Retinal fundus photograph
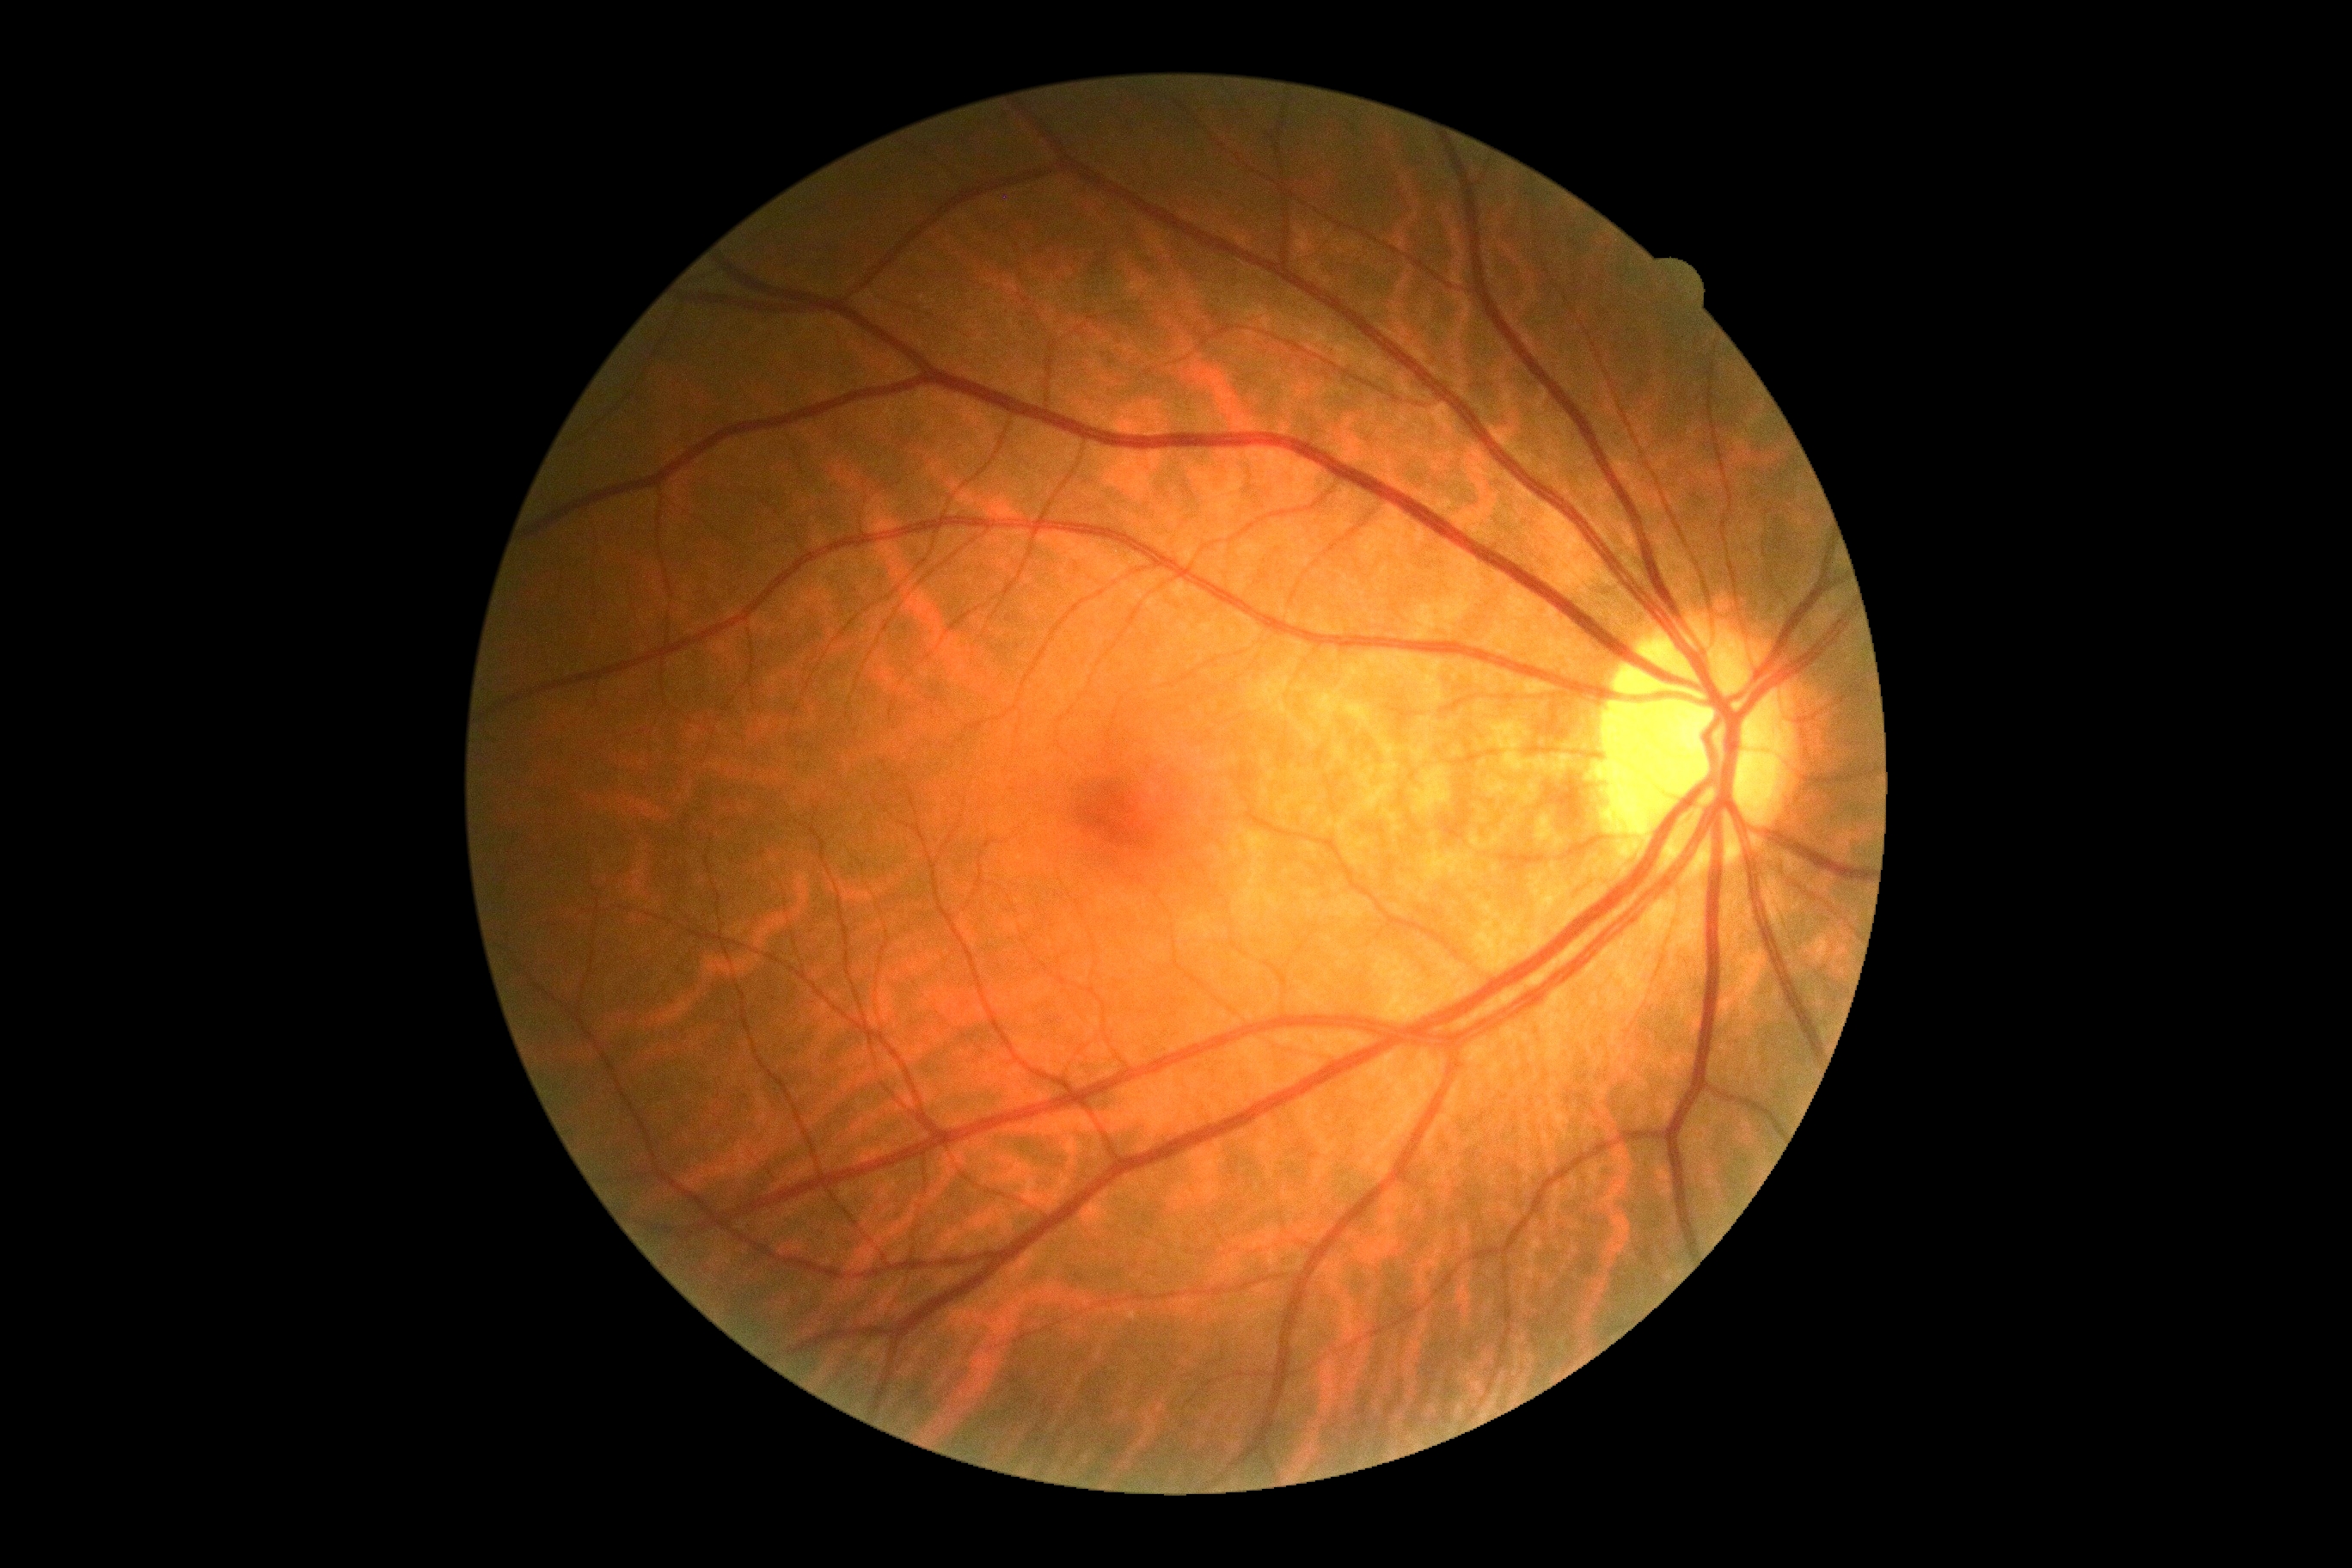 Retinopathy: no apparent diabetic retinopathy (grade 0).